Fundus image cropped to the optic disc. Dilated pupil: 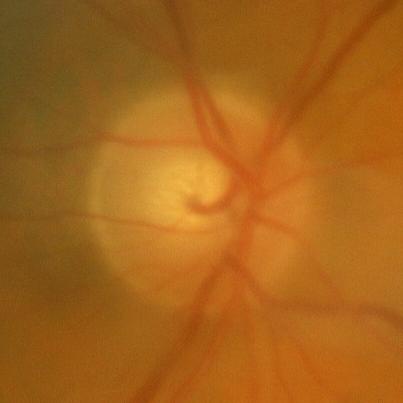
Glaucoma assessment: no glaucomatous optic neuropathy.